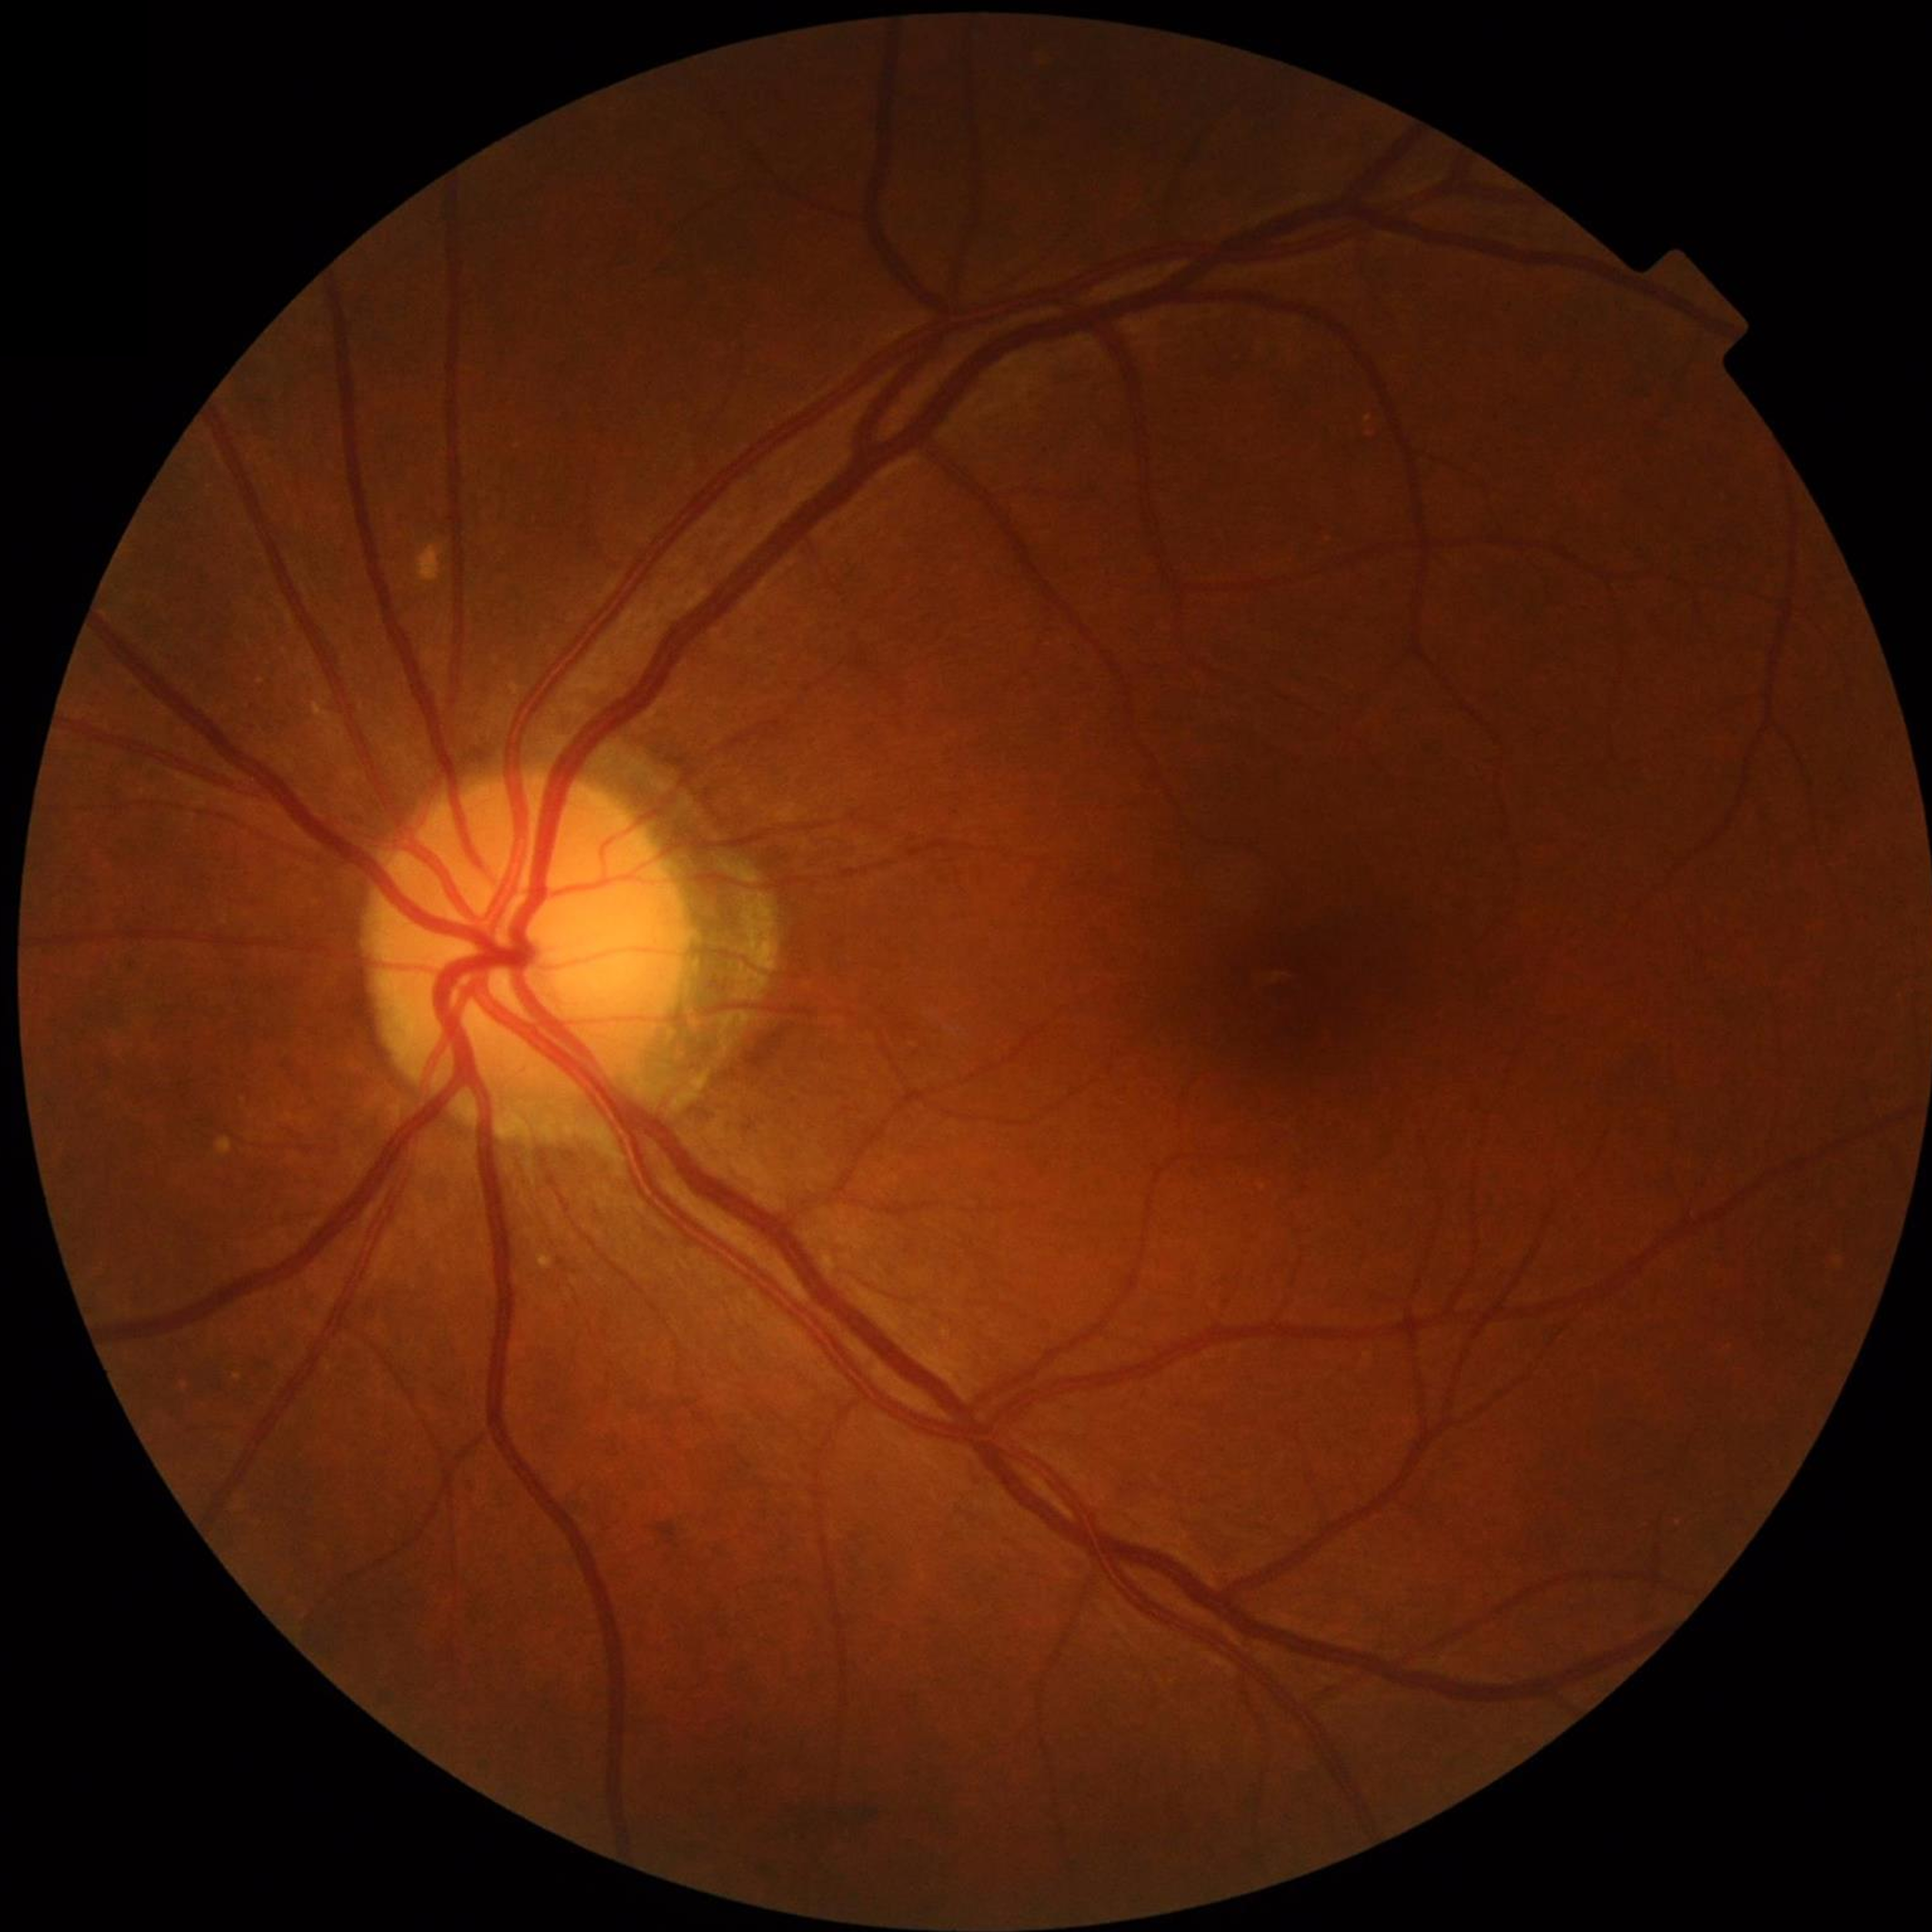

  diagnosis: no AMD, DR, or glaucomatous findings